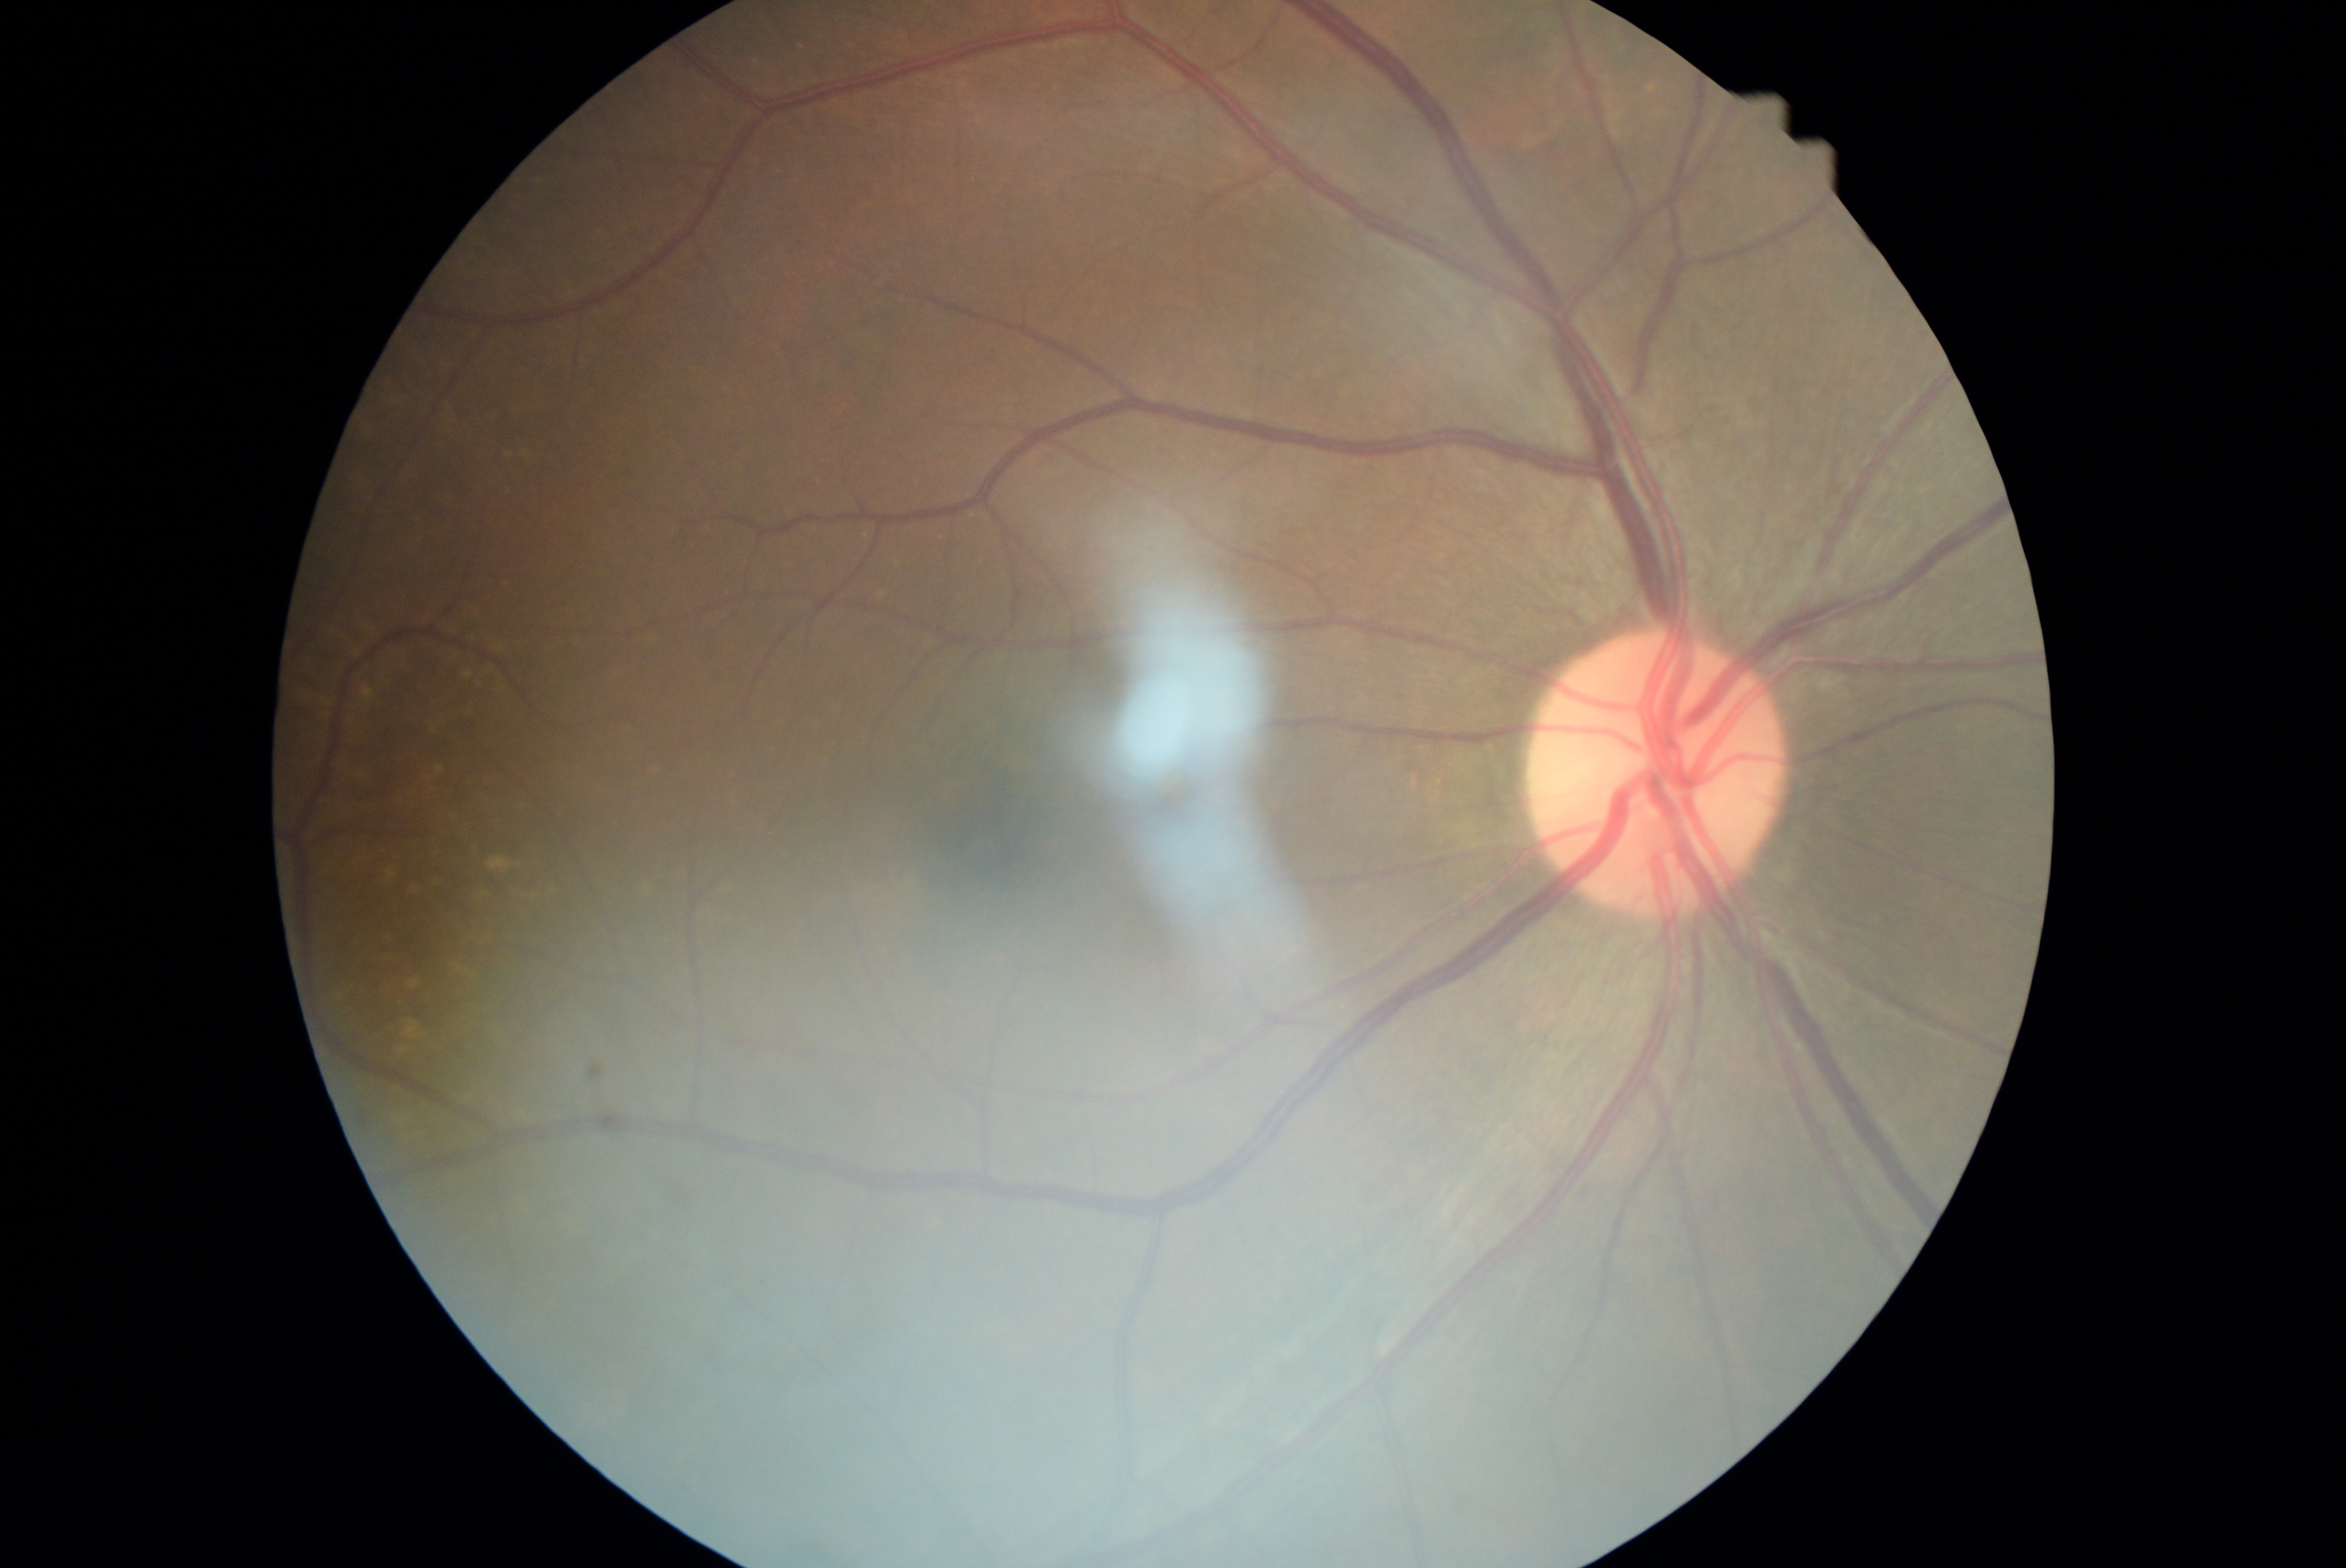 DR grade = 0/4.